Posterior pole photograph, 45° field of view, modified Davis classification, no pharmacologic dilation
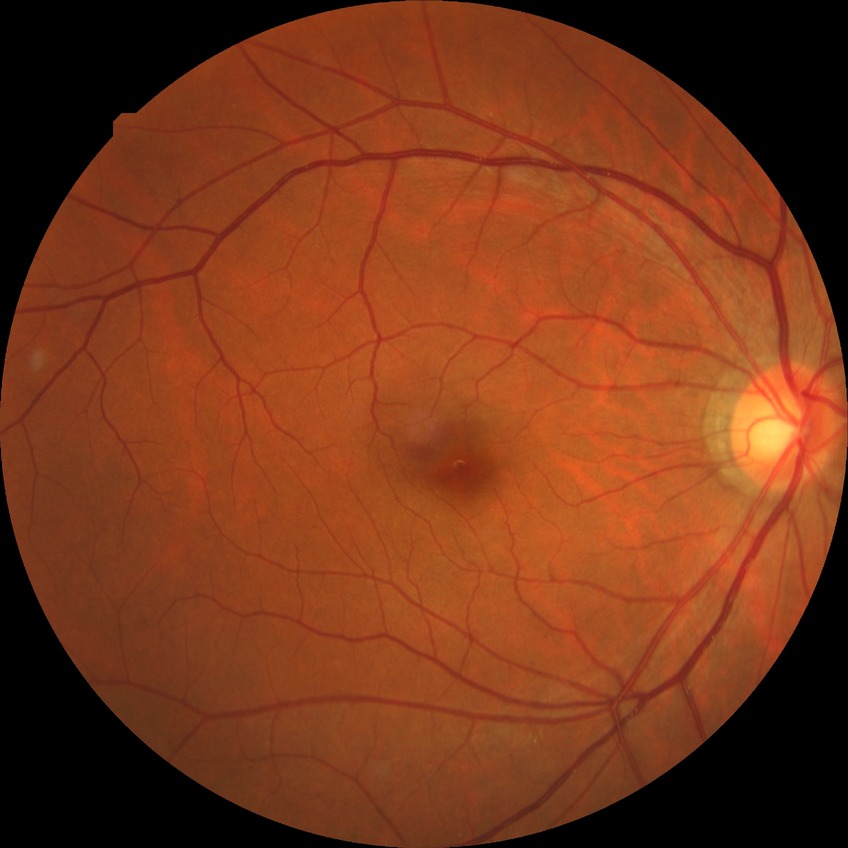 {"davis_grade": "NDR"}